Natus RetCam Envision, 130° FOV · infant wide-field fundus photograph · 1440 by 1080 pixels — 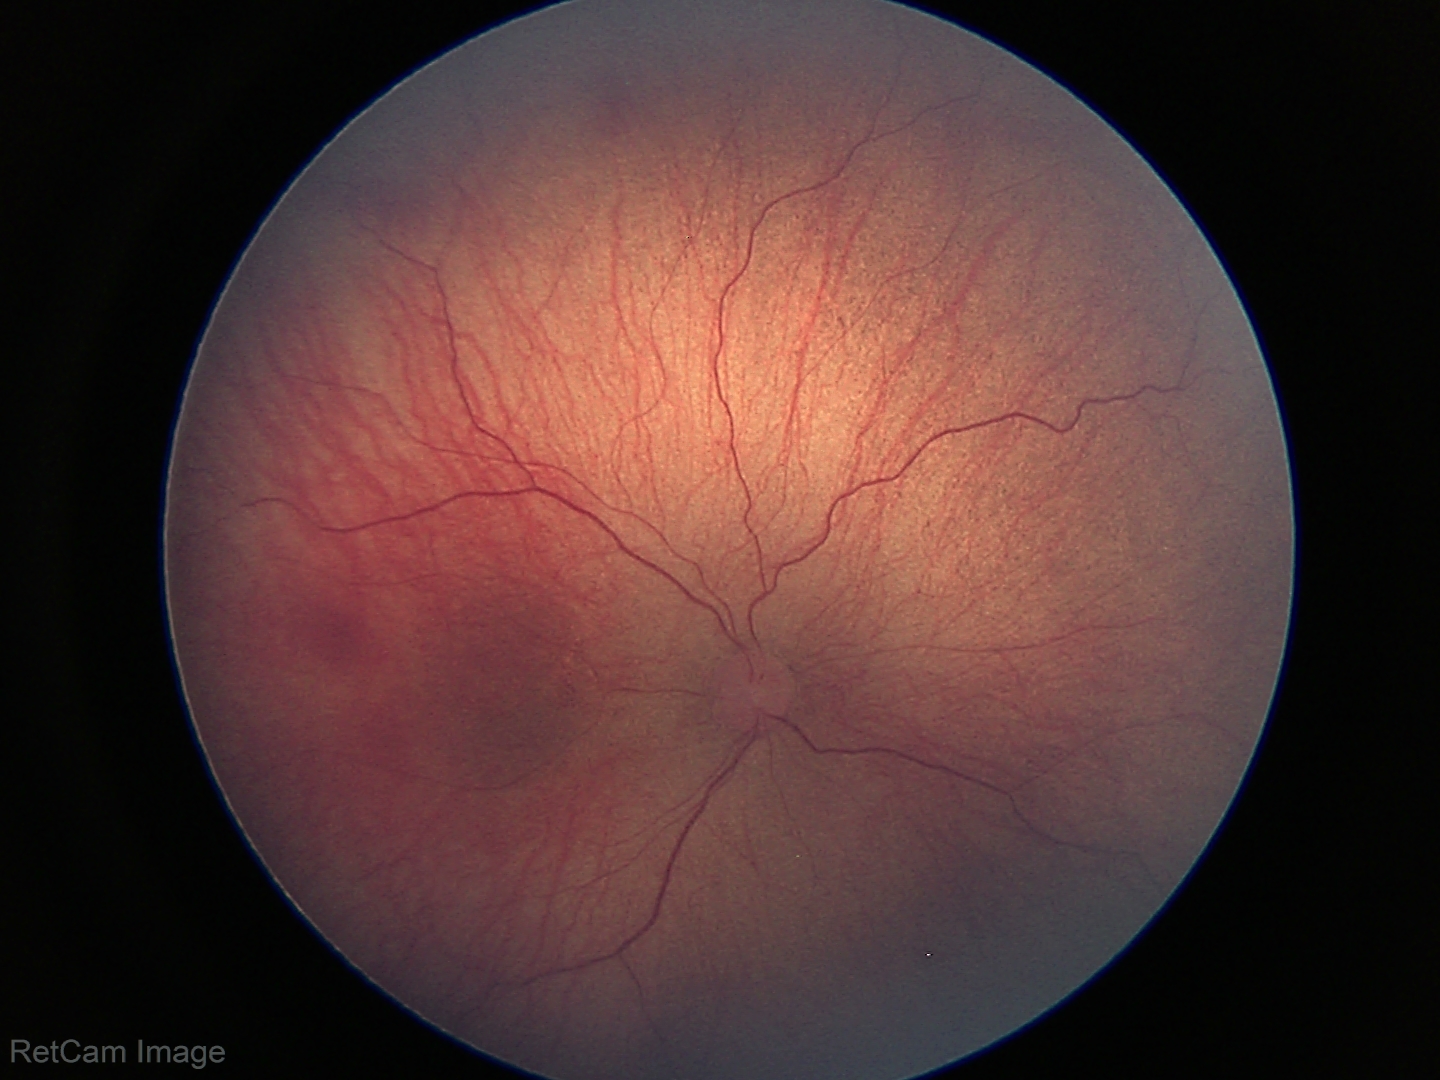

From an examination with diagnosis of retinopathy of prematurity stage 1 — demarcation line between vascular and avascular retina.